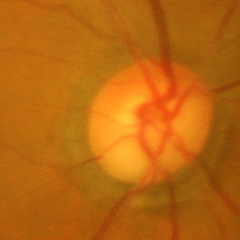 Optic disc photograph demonstrating advanced-stage glaucoma.